Infant wide-field fundus photograph · acquired on the Natus RetCam Envision
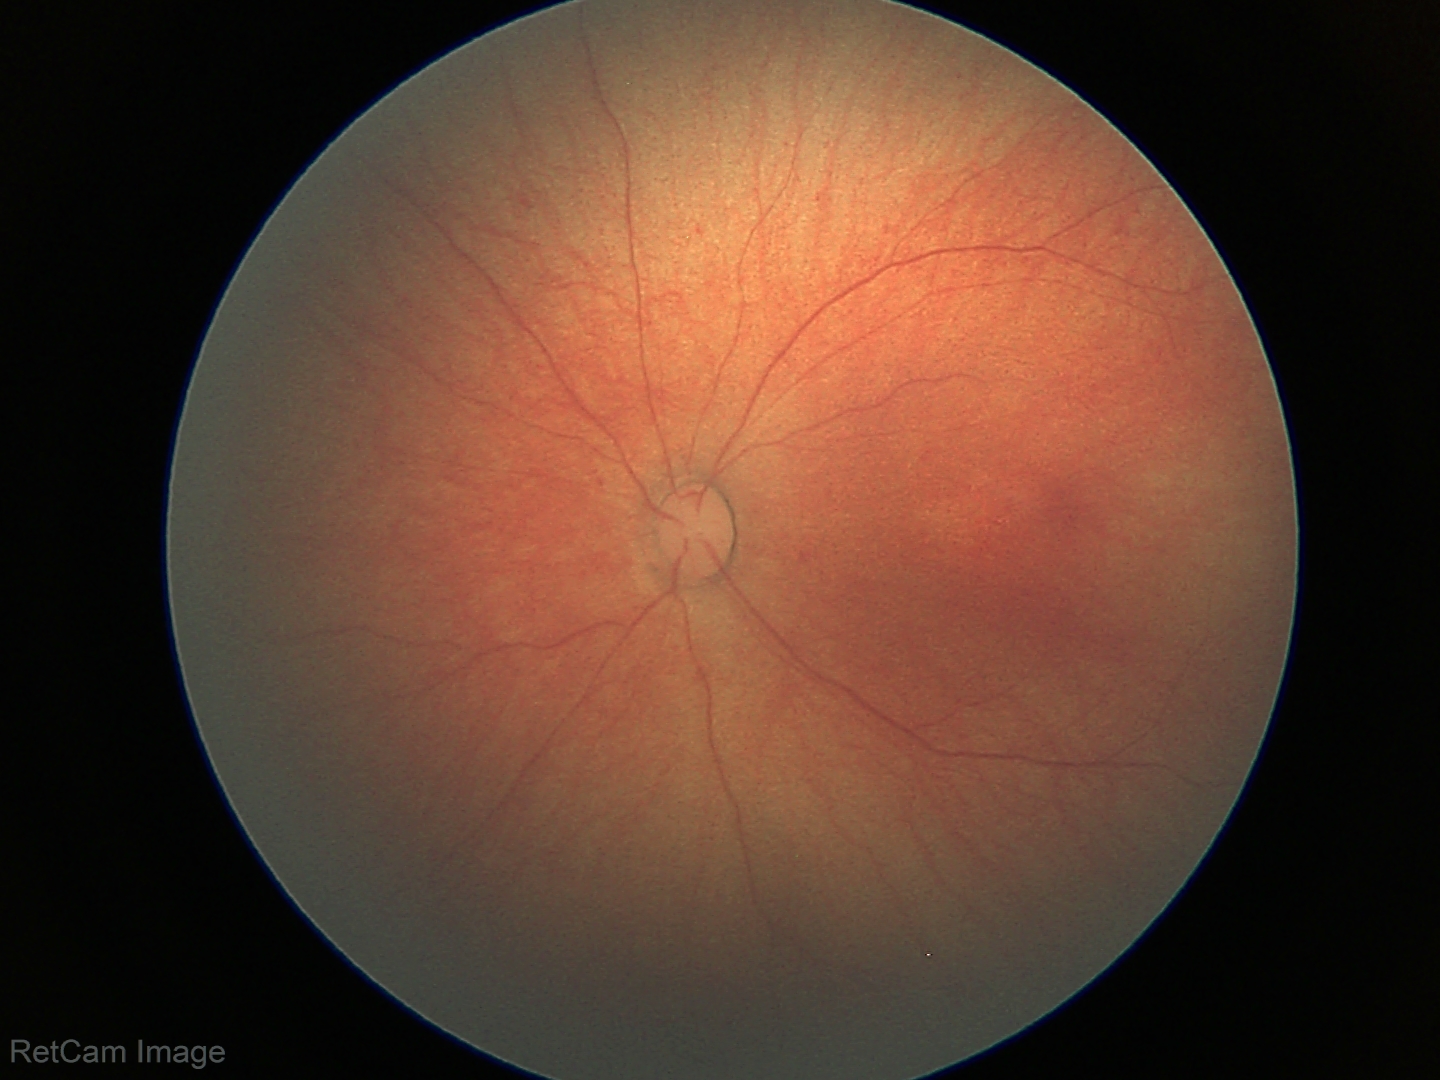 Physiological retinal appearance for postconceptual age.